Captured on a Nidek AFC-330 fundus camera, optic disc-centered crop:
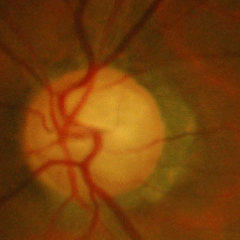 Assessment = early glaucoma. Defined as glaucomatous retinal nerve fiber layer defects on red-free fundus photography without visual field defects.